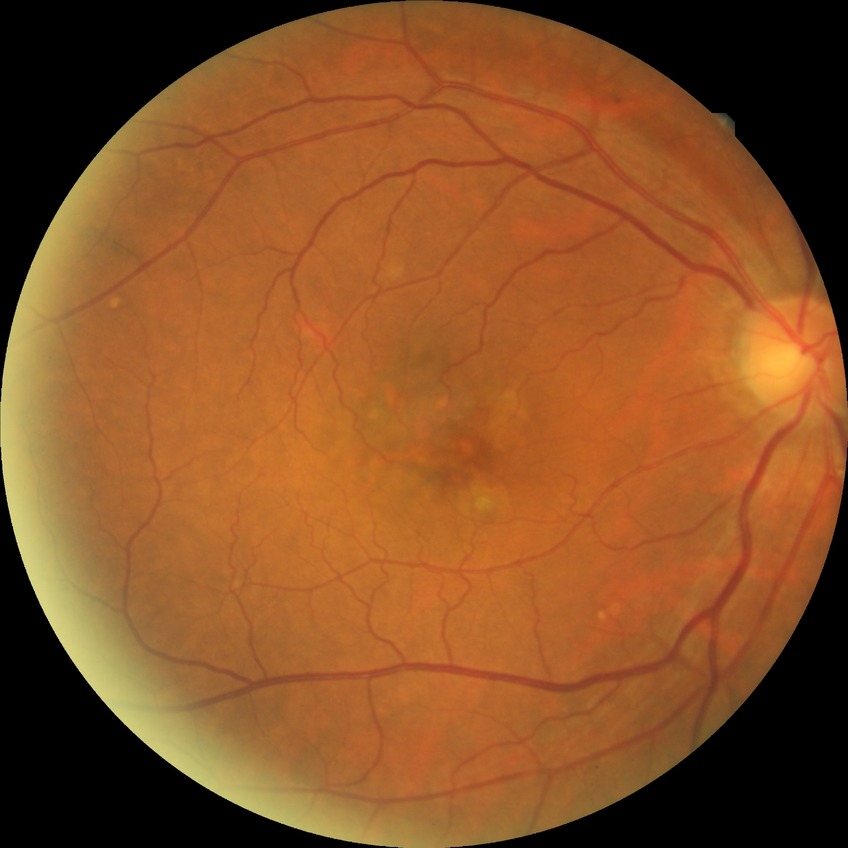 DR impression: no apparent DR | modified Davis grade: NDR.